Graded on the modified Davis scale
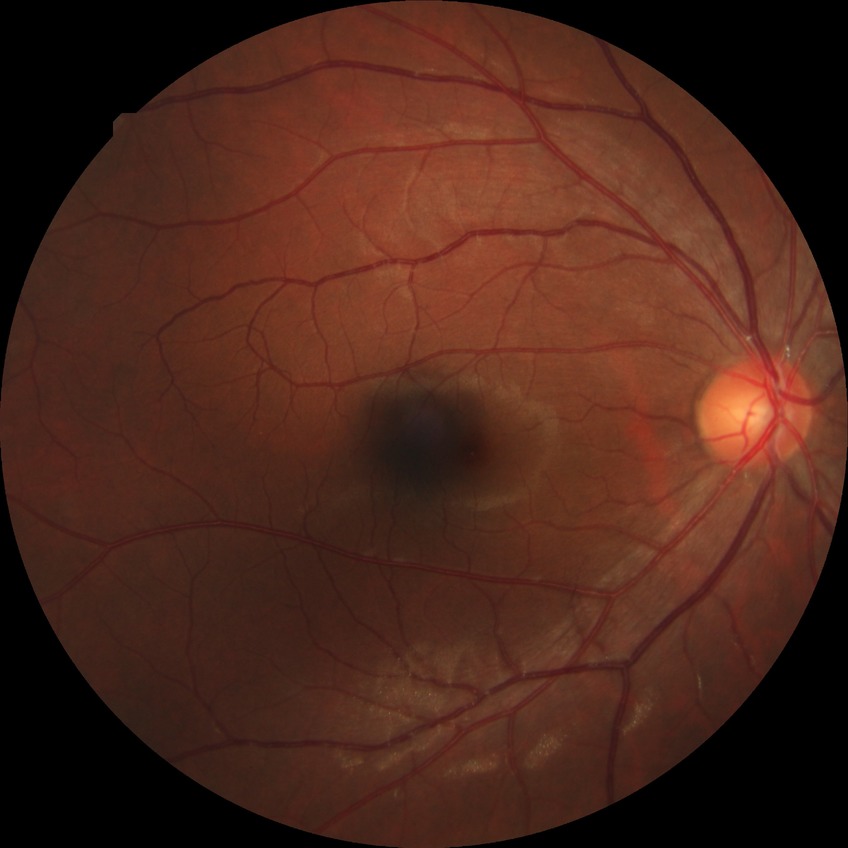

Diabetic retinopathy (DR): NDR (no diabetic retinopathy).